Fundus photo. 512 x 512 pixels — 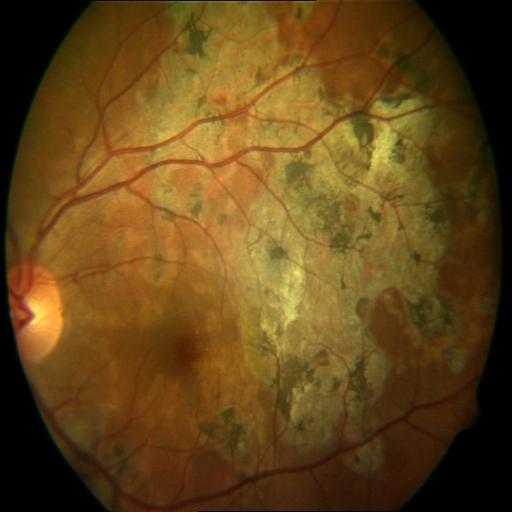 The image shows macular scar.